Modified Davis classification. 848x848
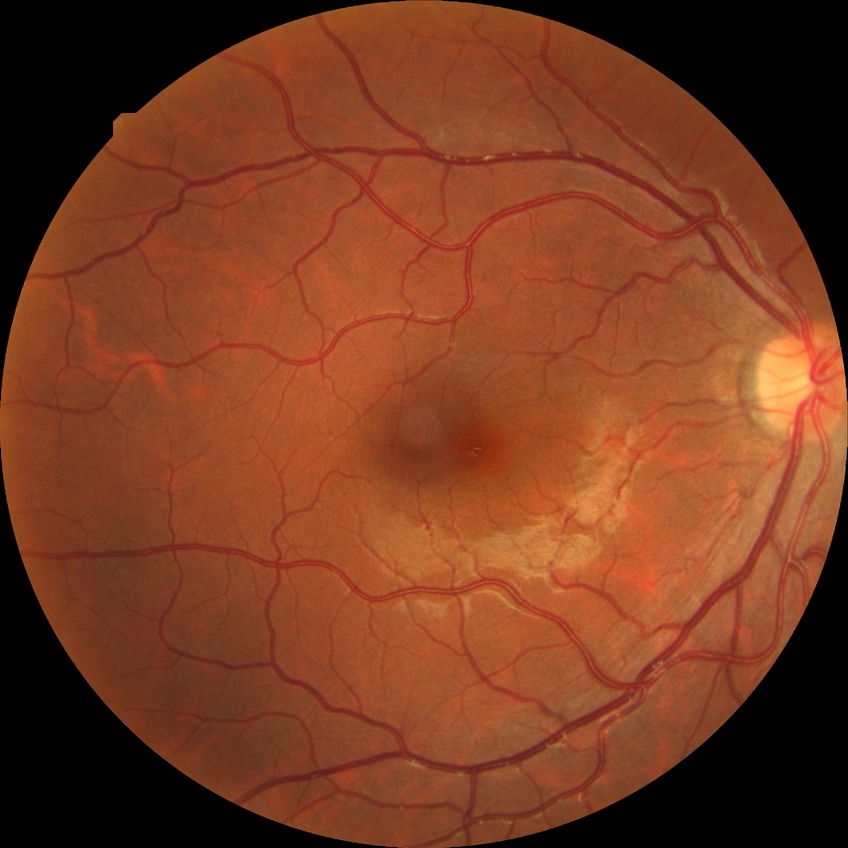
Diabetic retinopathy (DR): no diabetic retinopathy (NDR).